Infant wide-field retinal image: 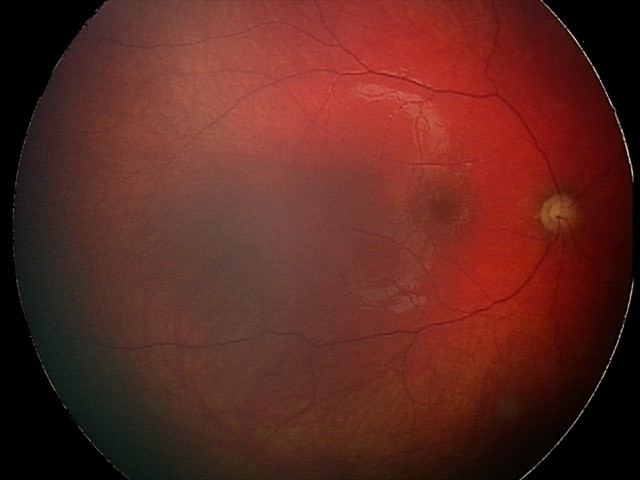 Screening series with optic nerve hypoplasia.